Color fundus image. 45° FOV. 2212x1659px:
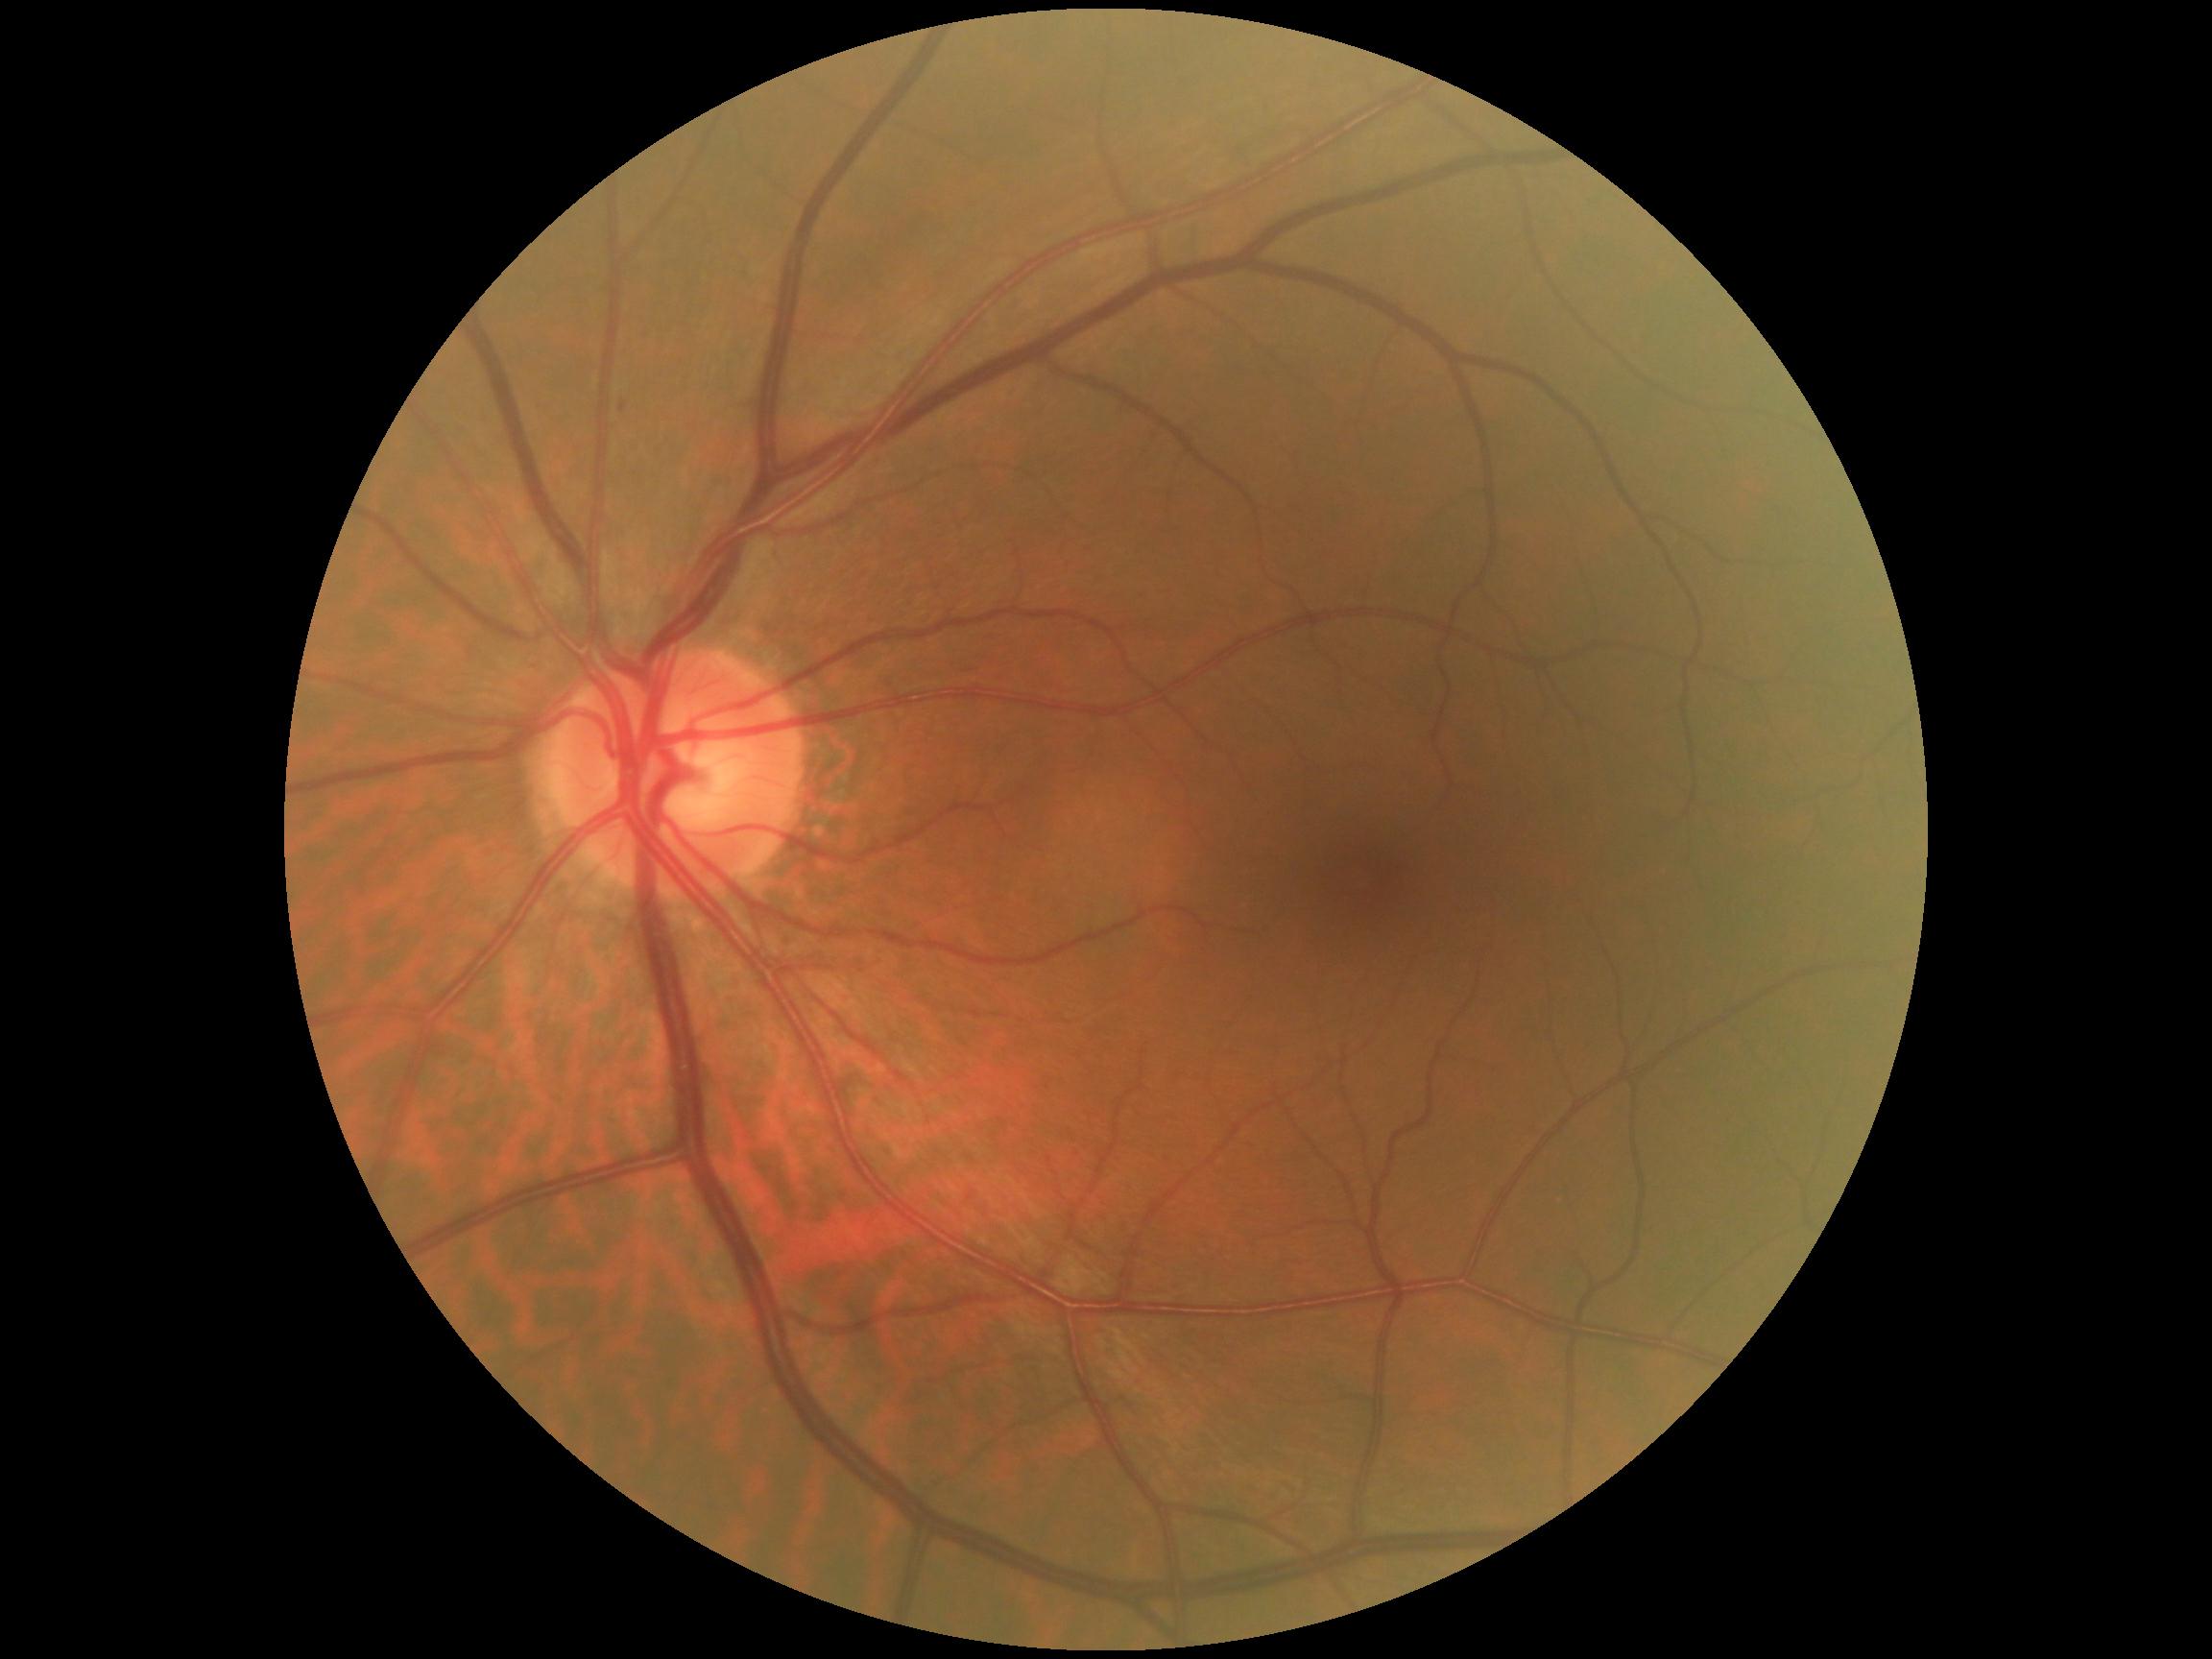

DR grade: 1/4 — presence of microaneurysms only.